DR severity per modified Davis staging; NIDEK AFC-230; nonmydriatic:
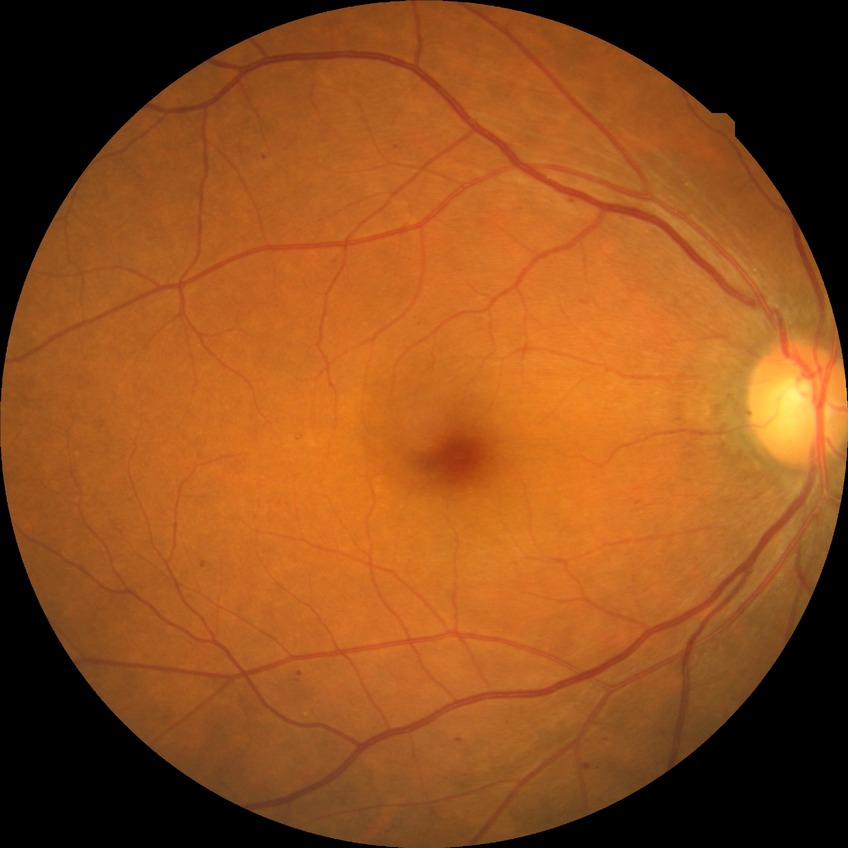

DR stage is SDR.